2048x1536 — 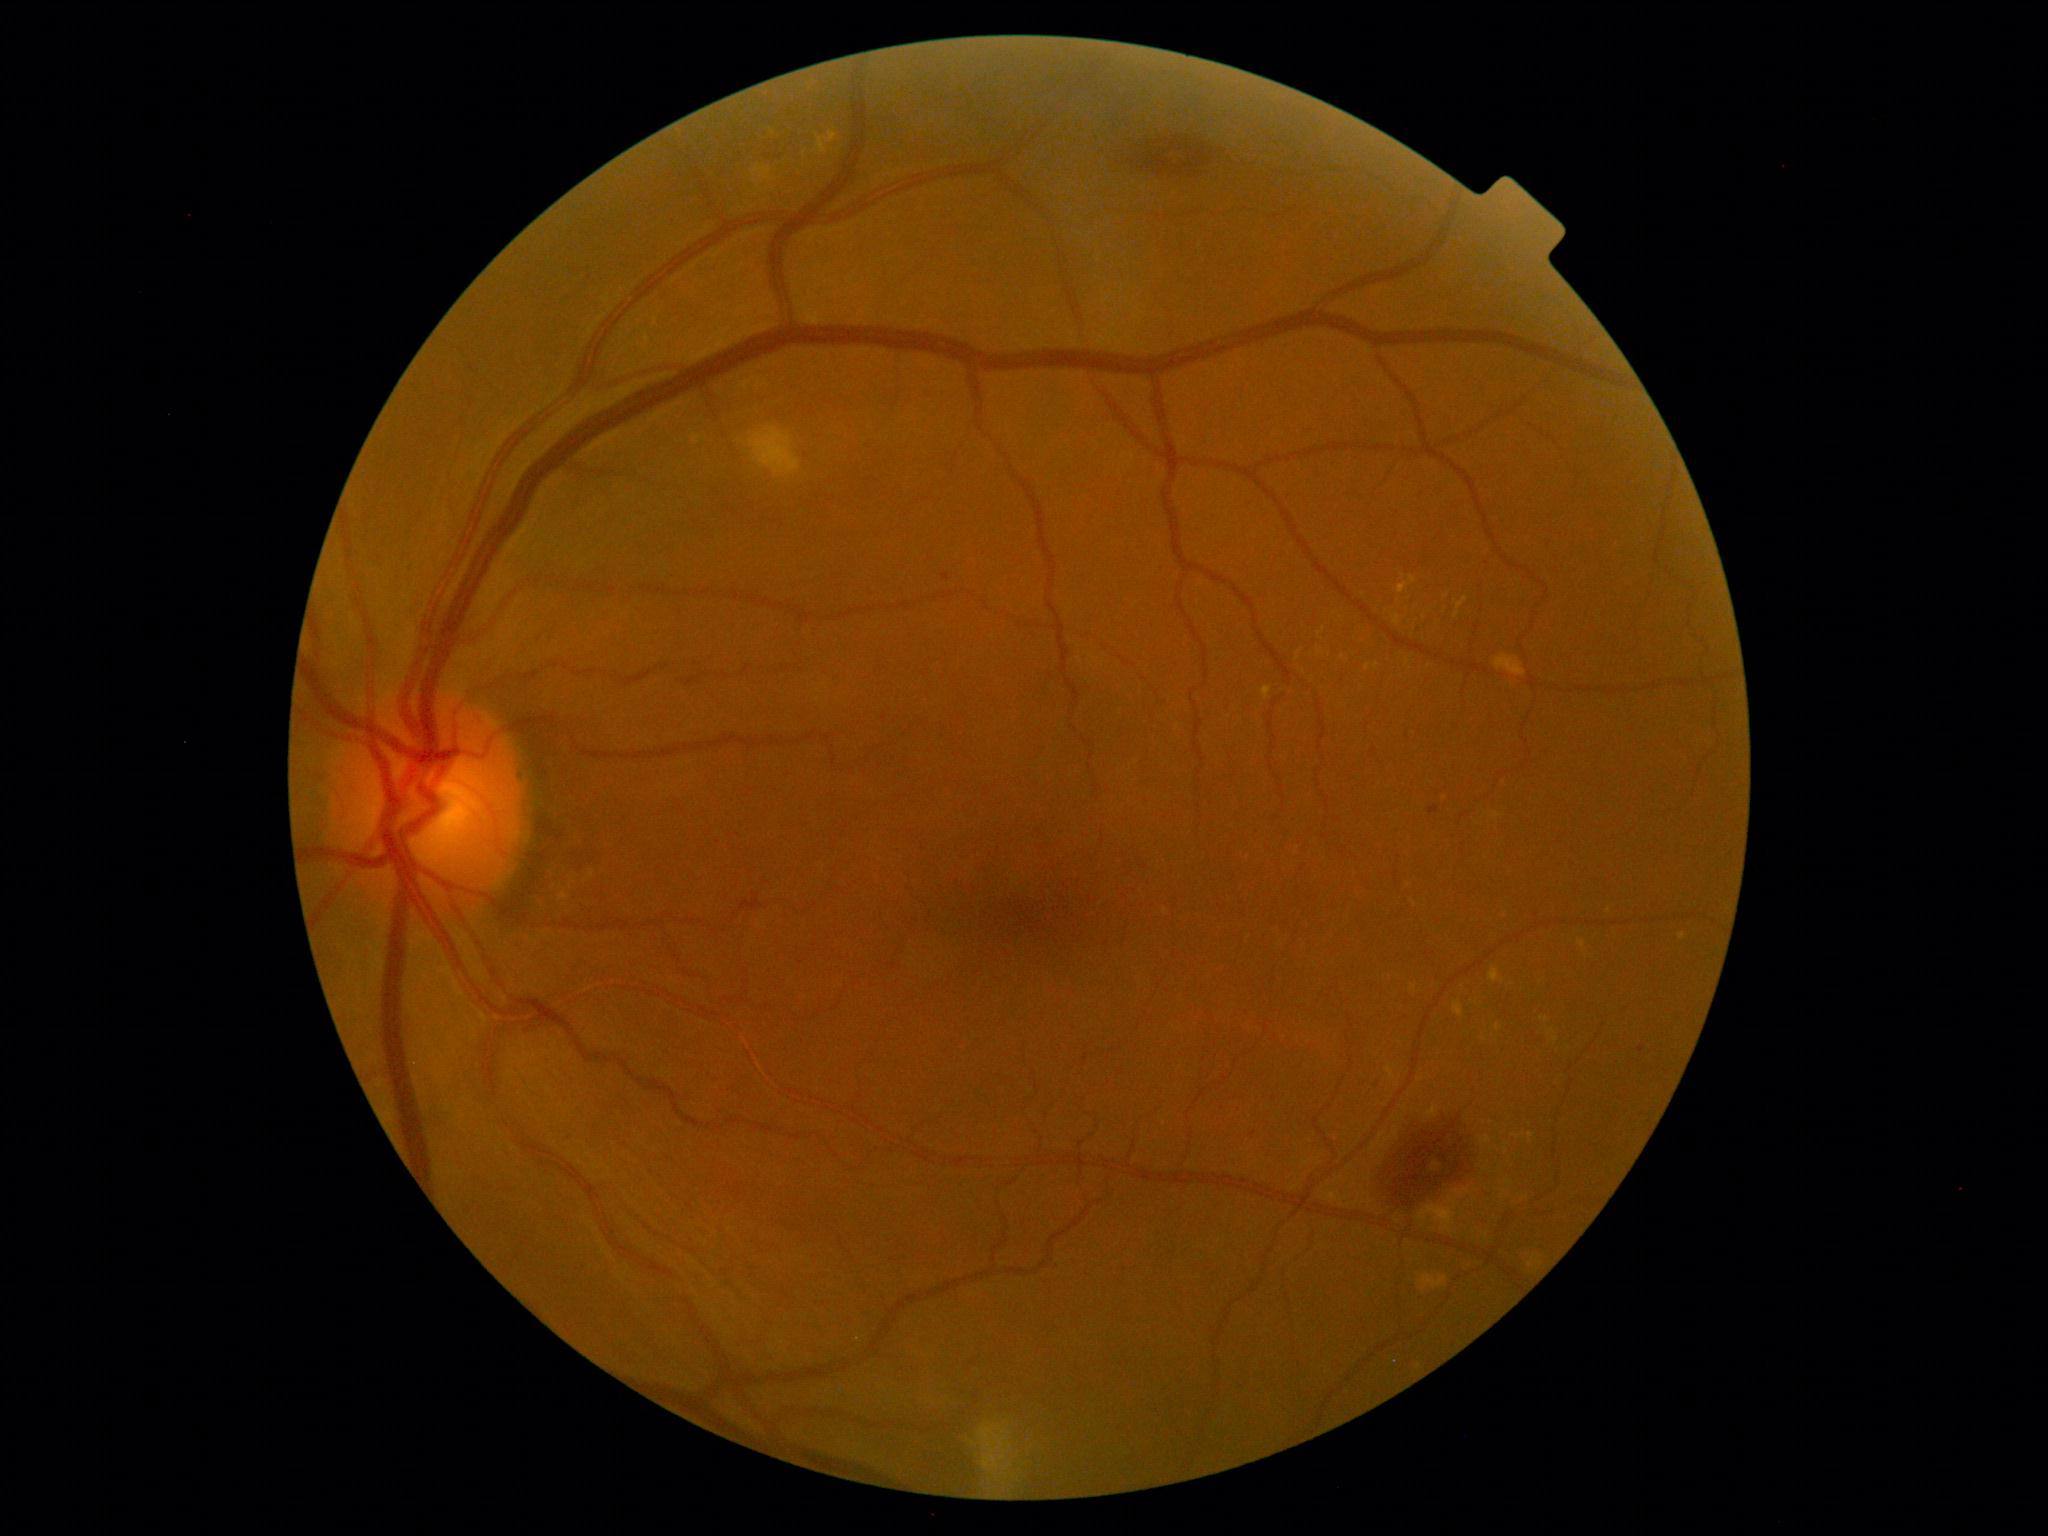

DR is grade 2 (moderate NPDR).